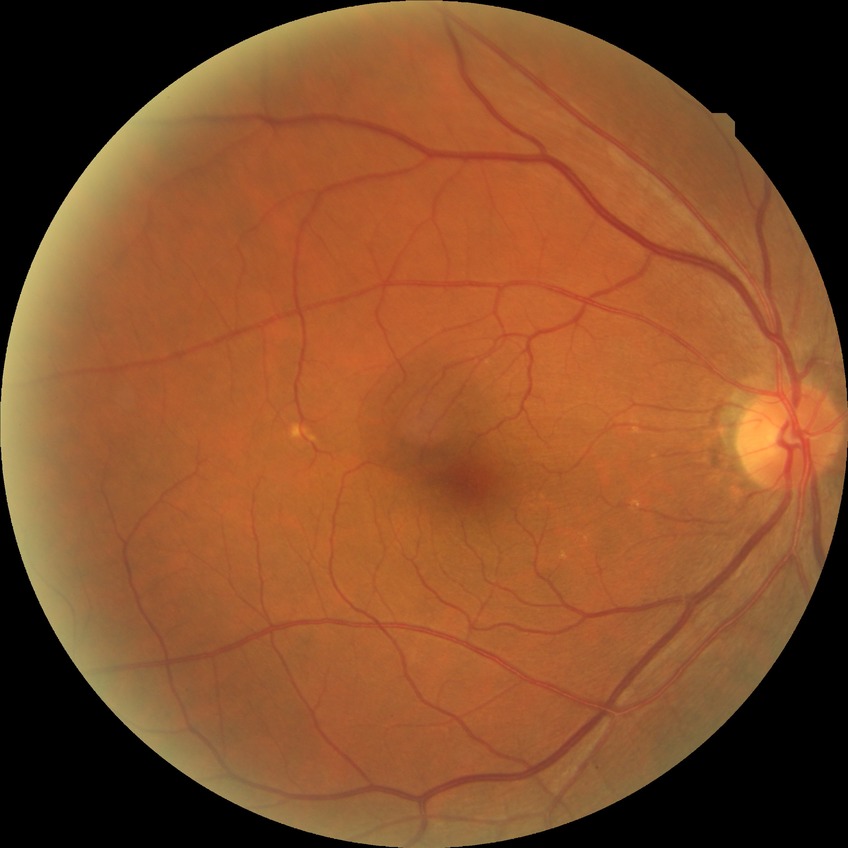
Findings:
- diabetic retinopathy (DR) — NDR (no diabetic retinopathy)